2048 by 1536 pixels
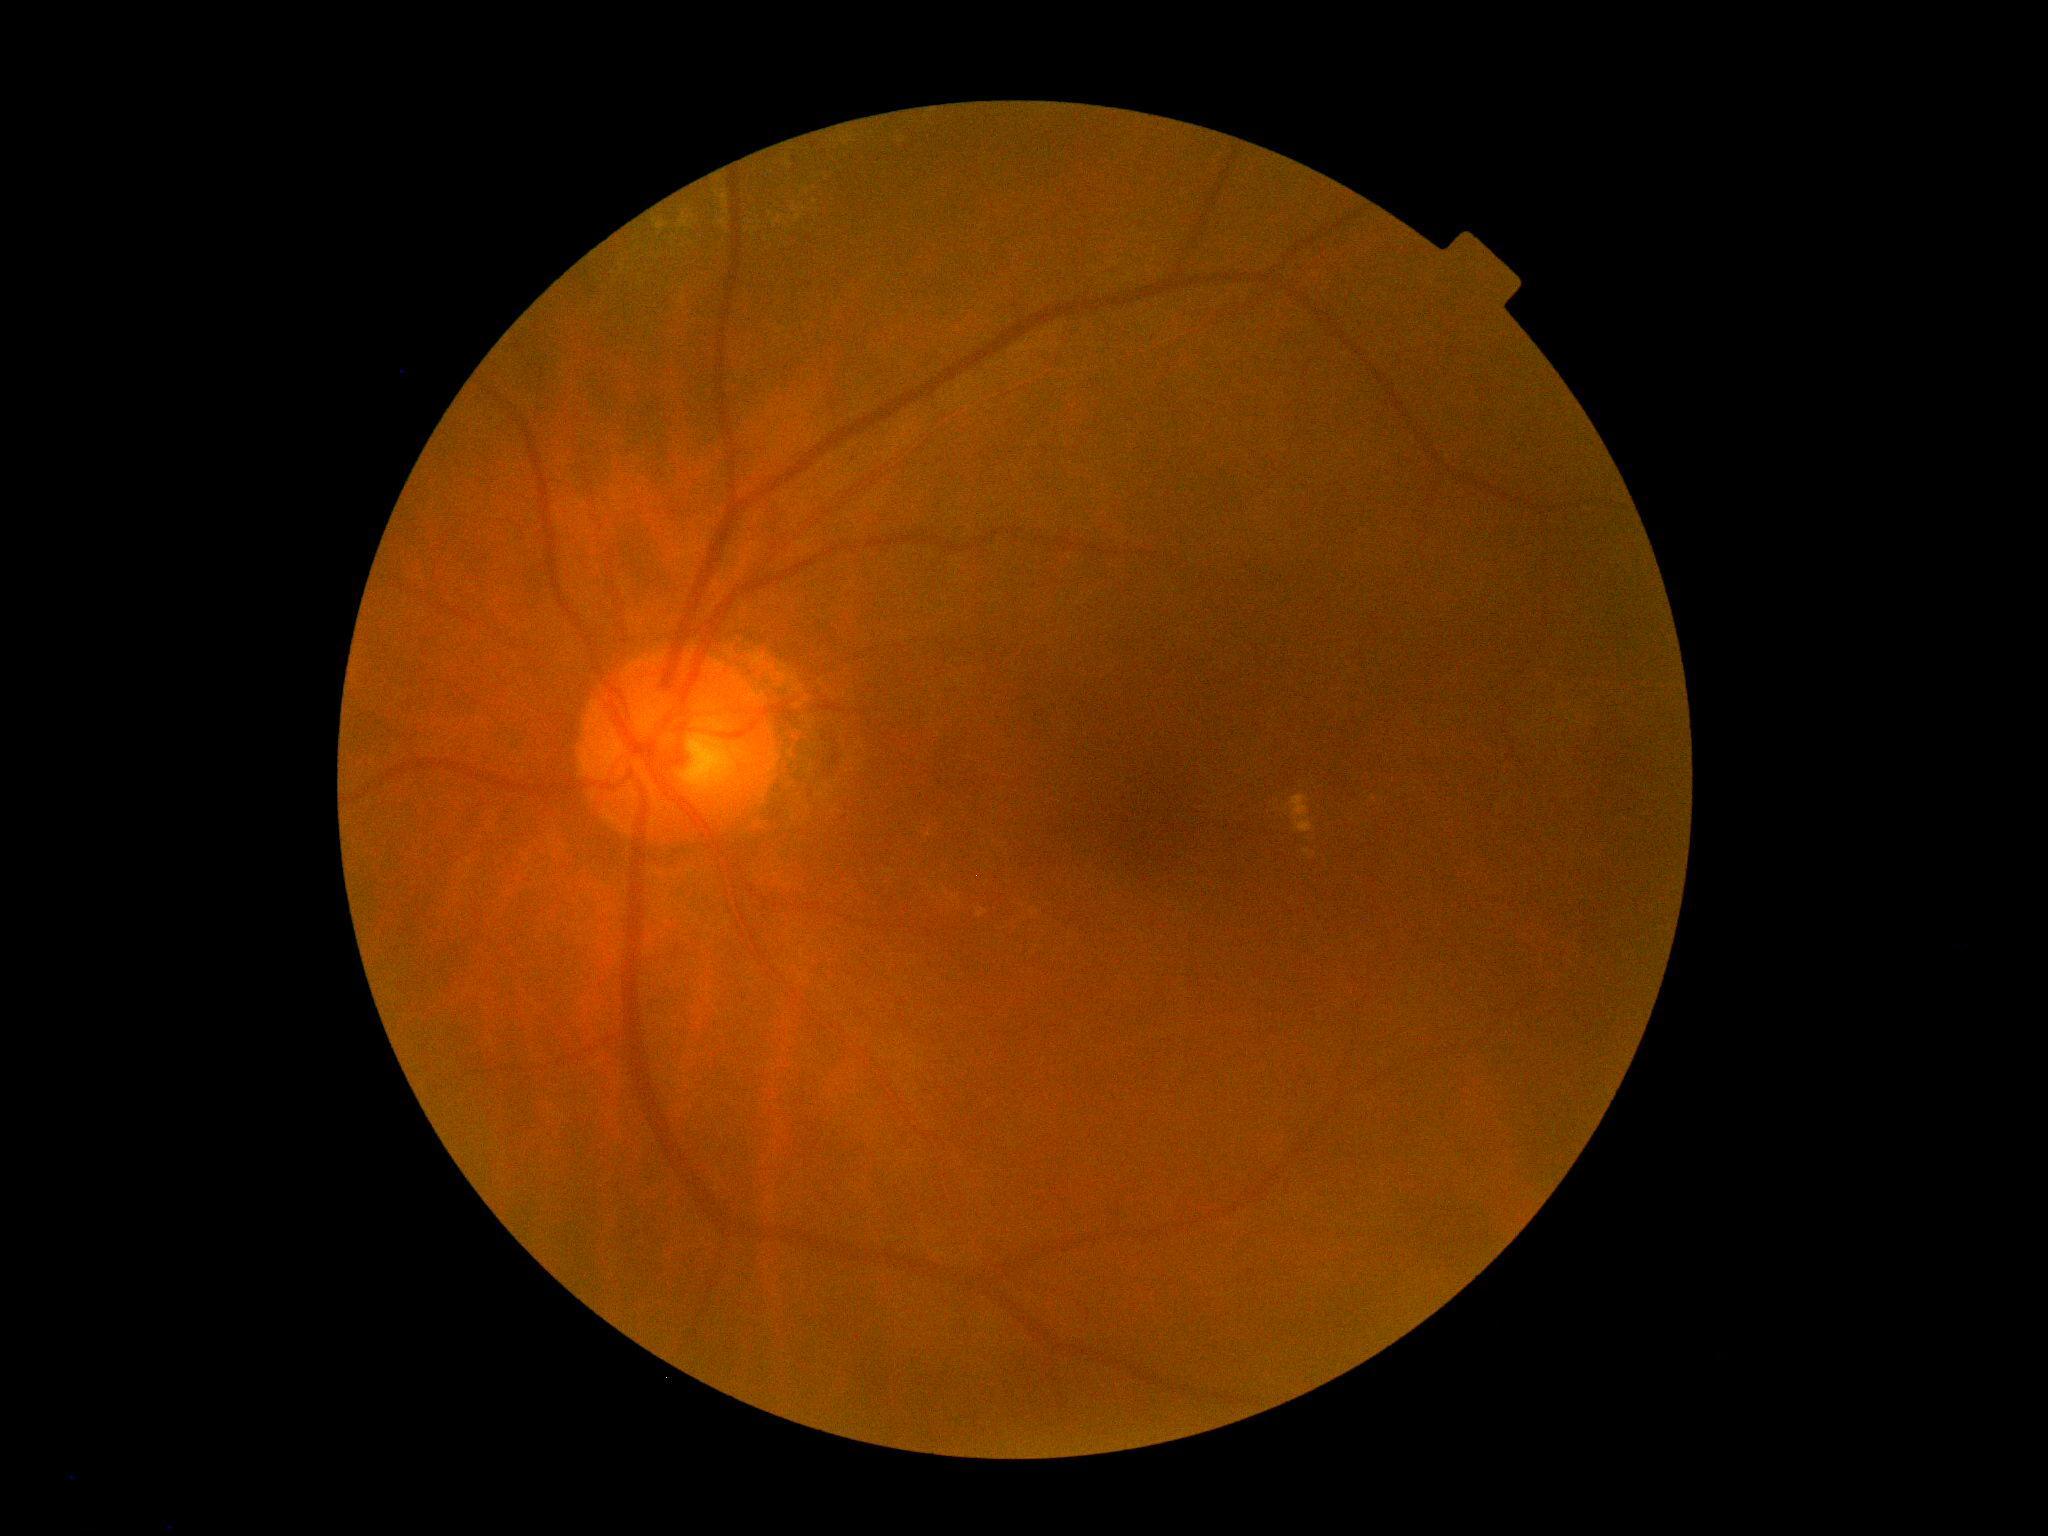

  dr_category: non-proliferative diabetic retinopathy
  dr_grade: 2 — more than just microaneurysms but less than severe NPDR